45° field of view:
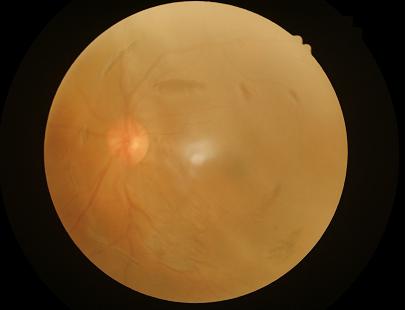 Image quality is inadequate for diagnostic use. Contrast is low. Illumination is even. Reduced sharpness with visible blur.